Ultra-widefield fundus mosaic; image size 1924x1556 — 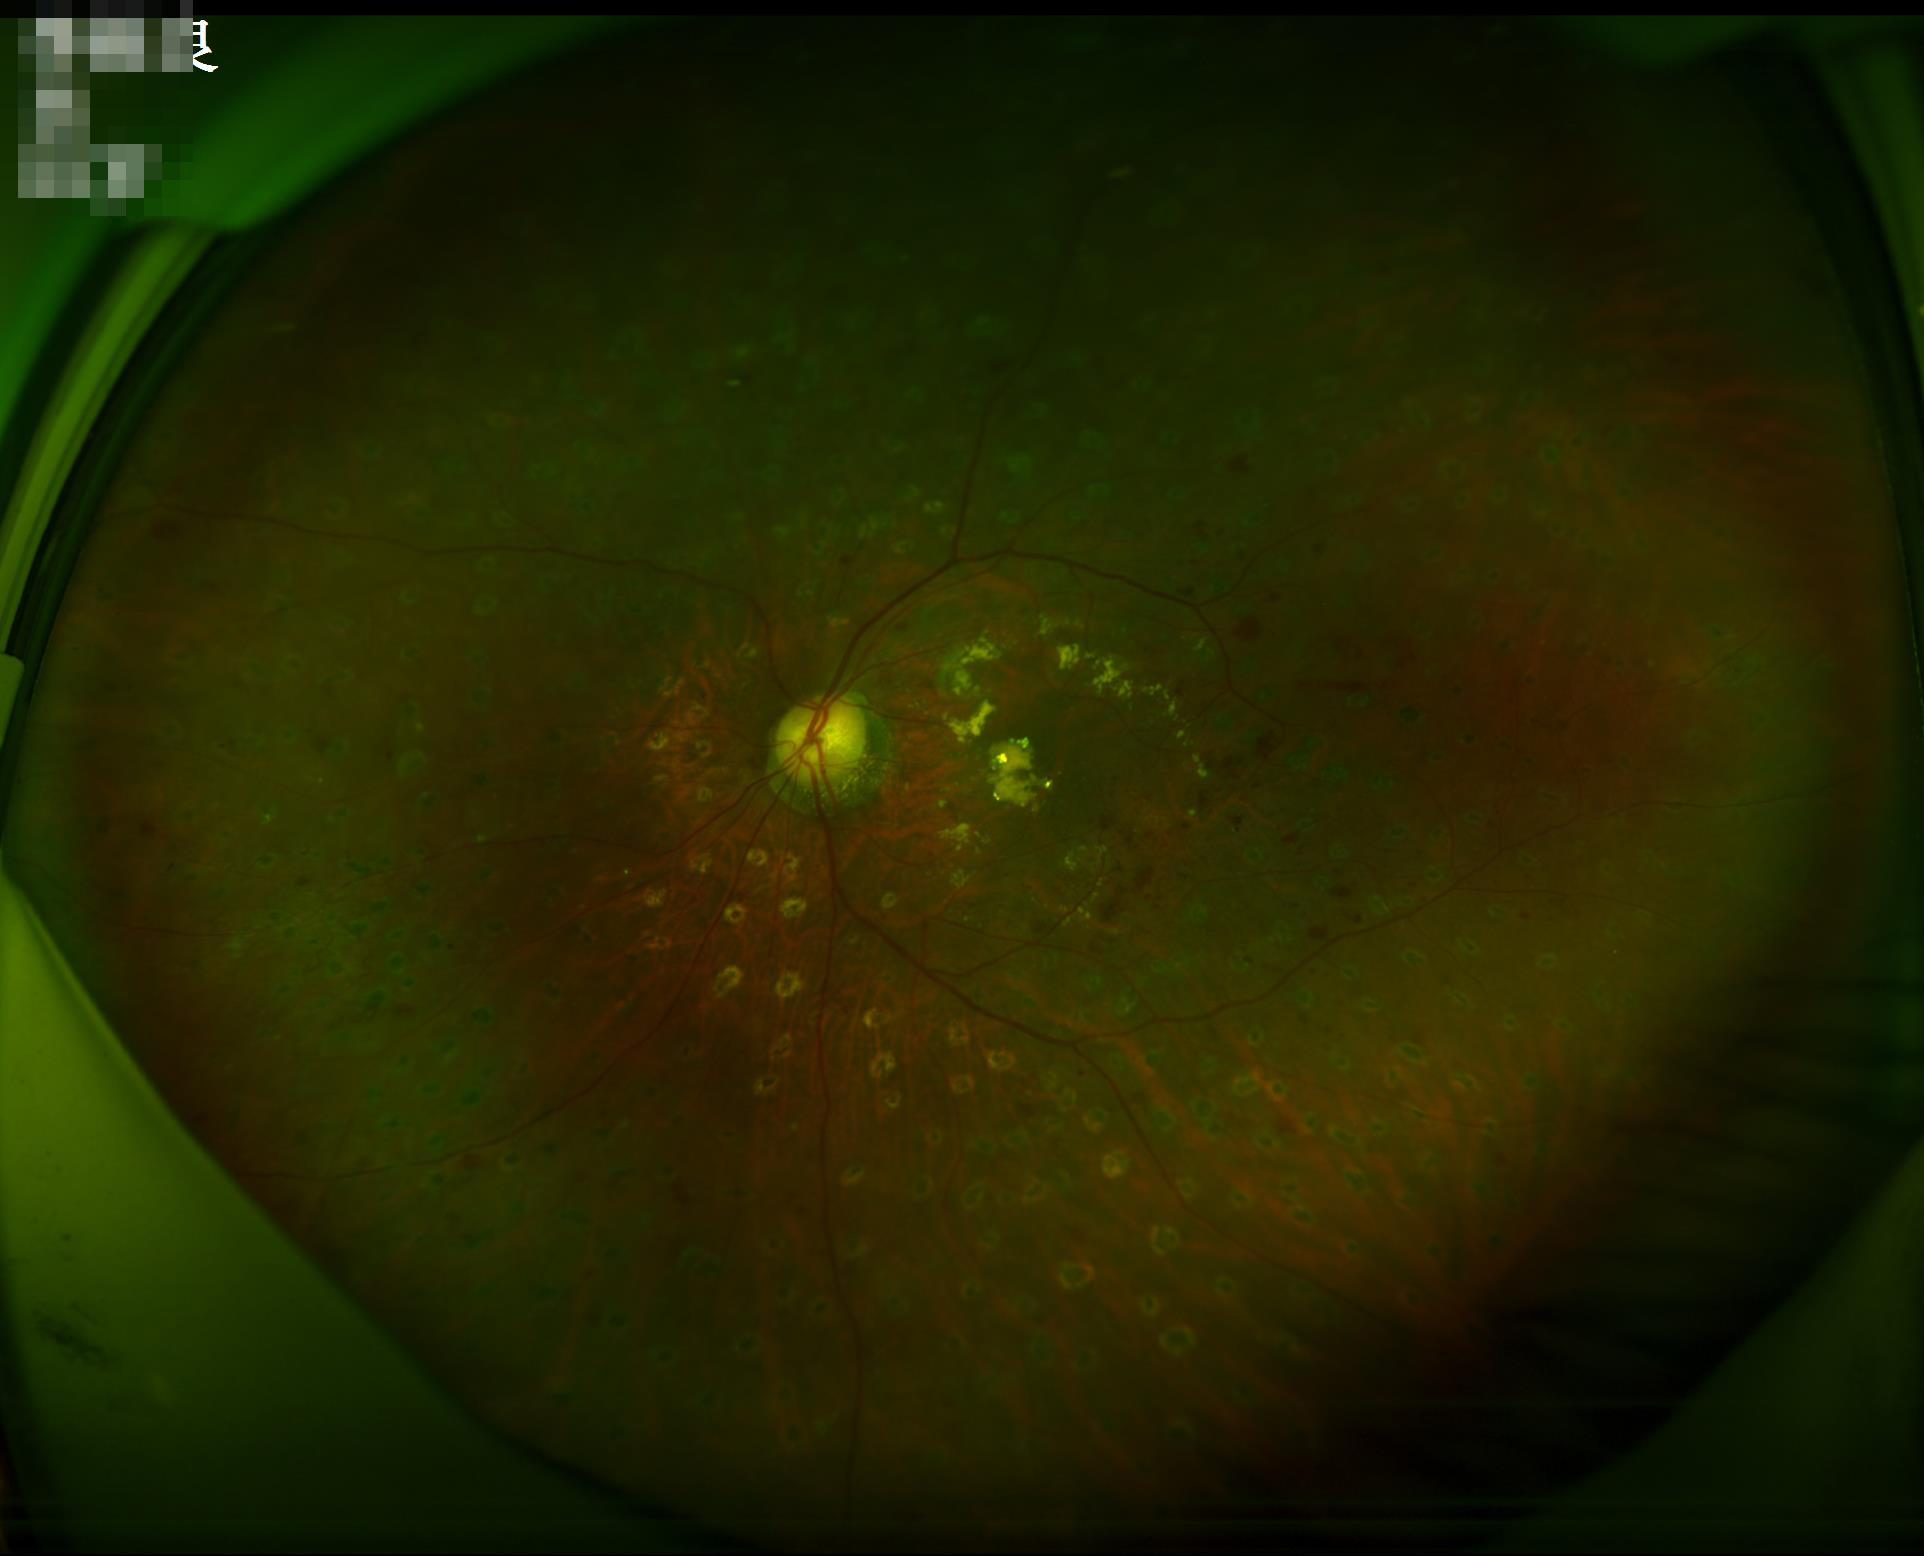

Image quality: illumination: uneven | sharpness: in focus.